Without pupil dilation; 45° field of view; retinal fundus photograph:
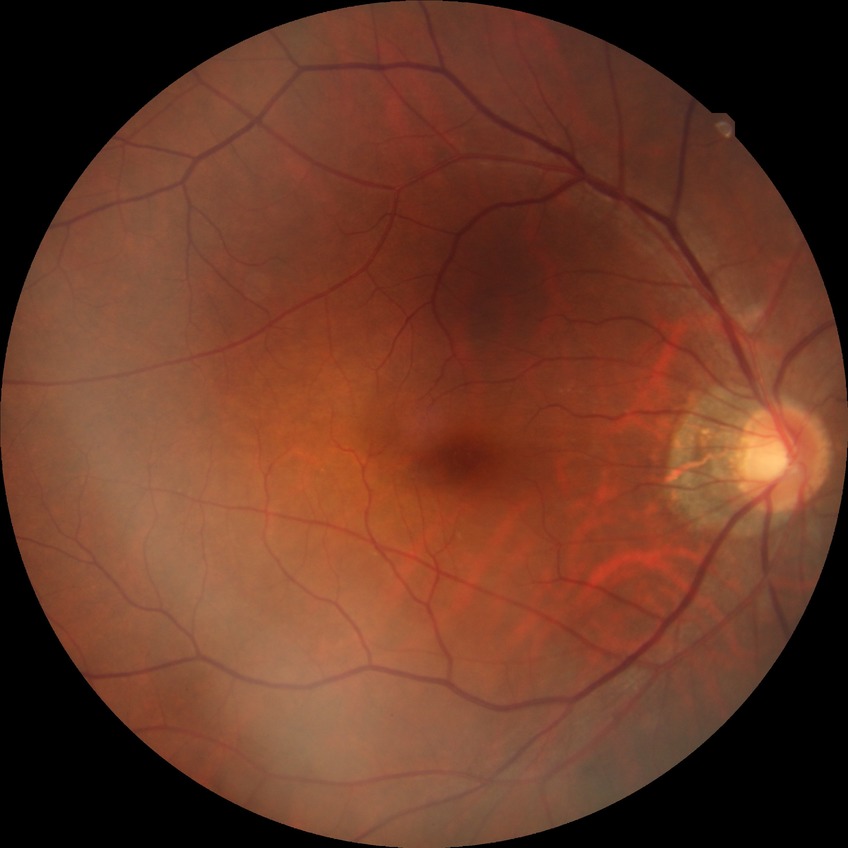

Diabetic retinopathy (DR): NDR (no diabetic retinopathy).